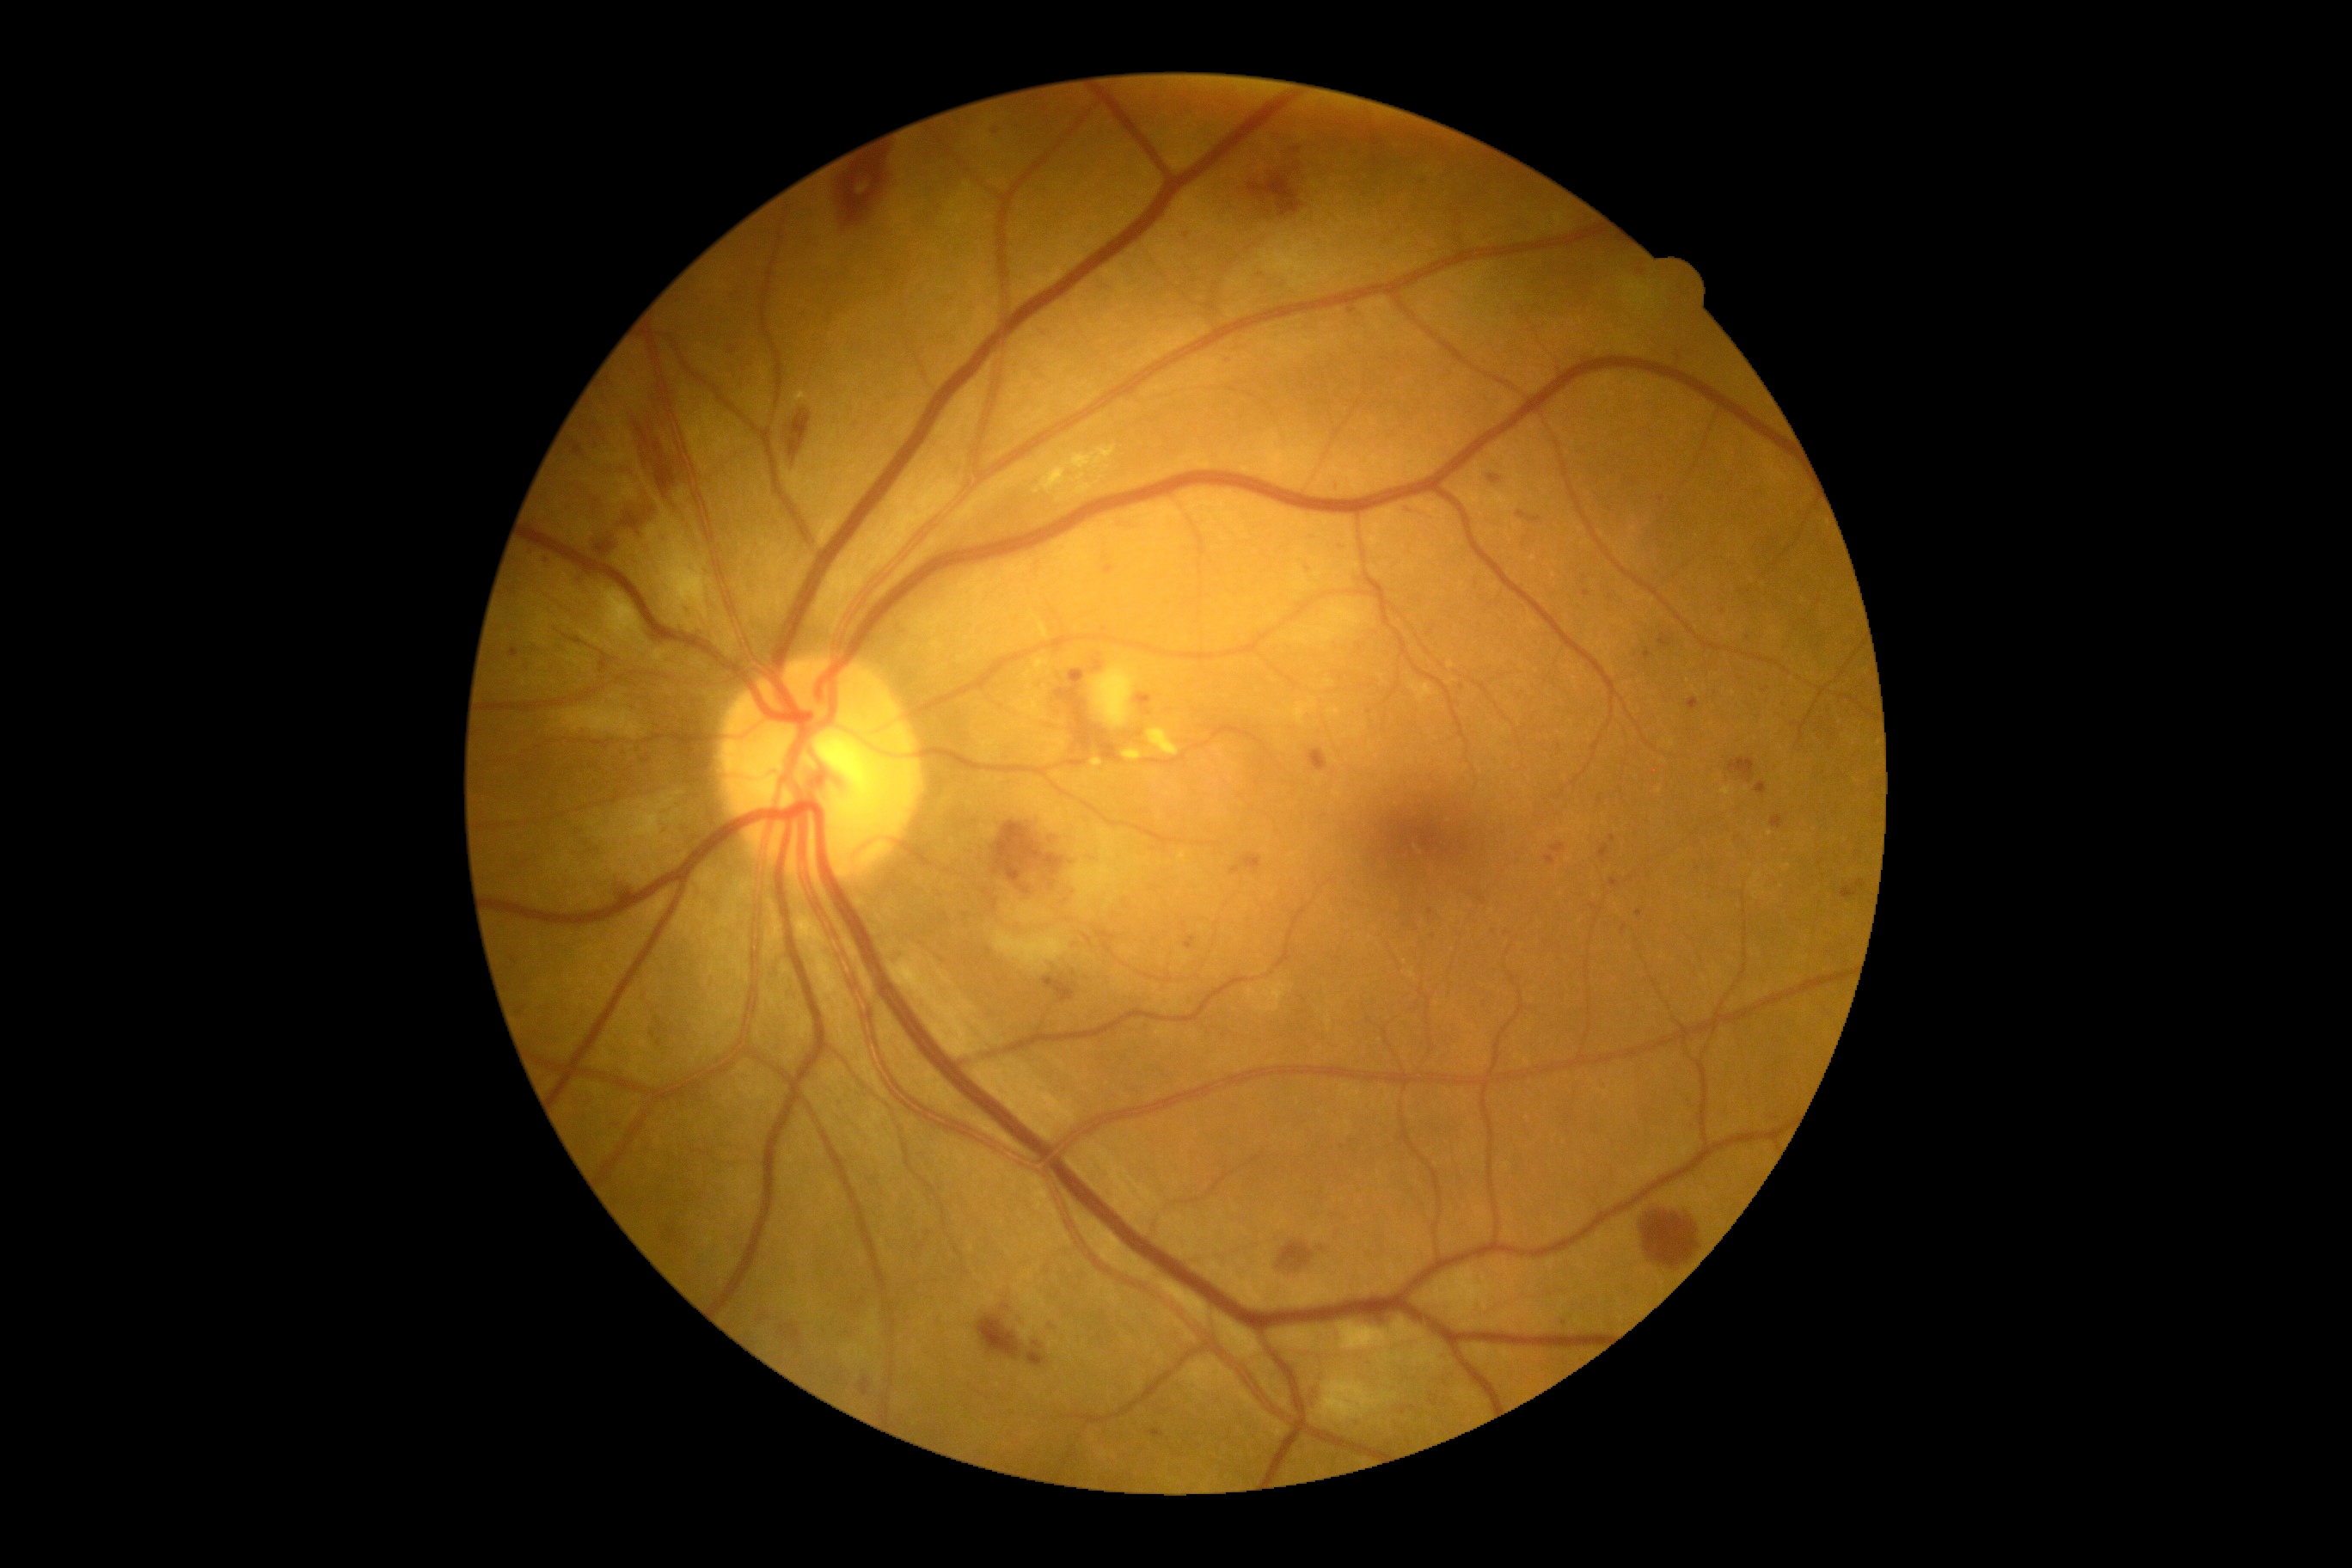

dr_grade: 2